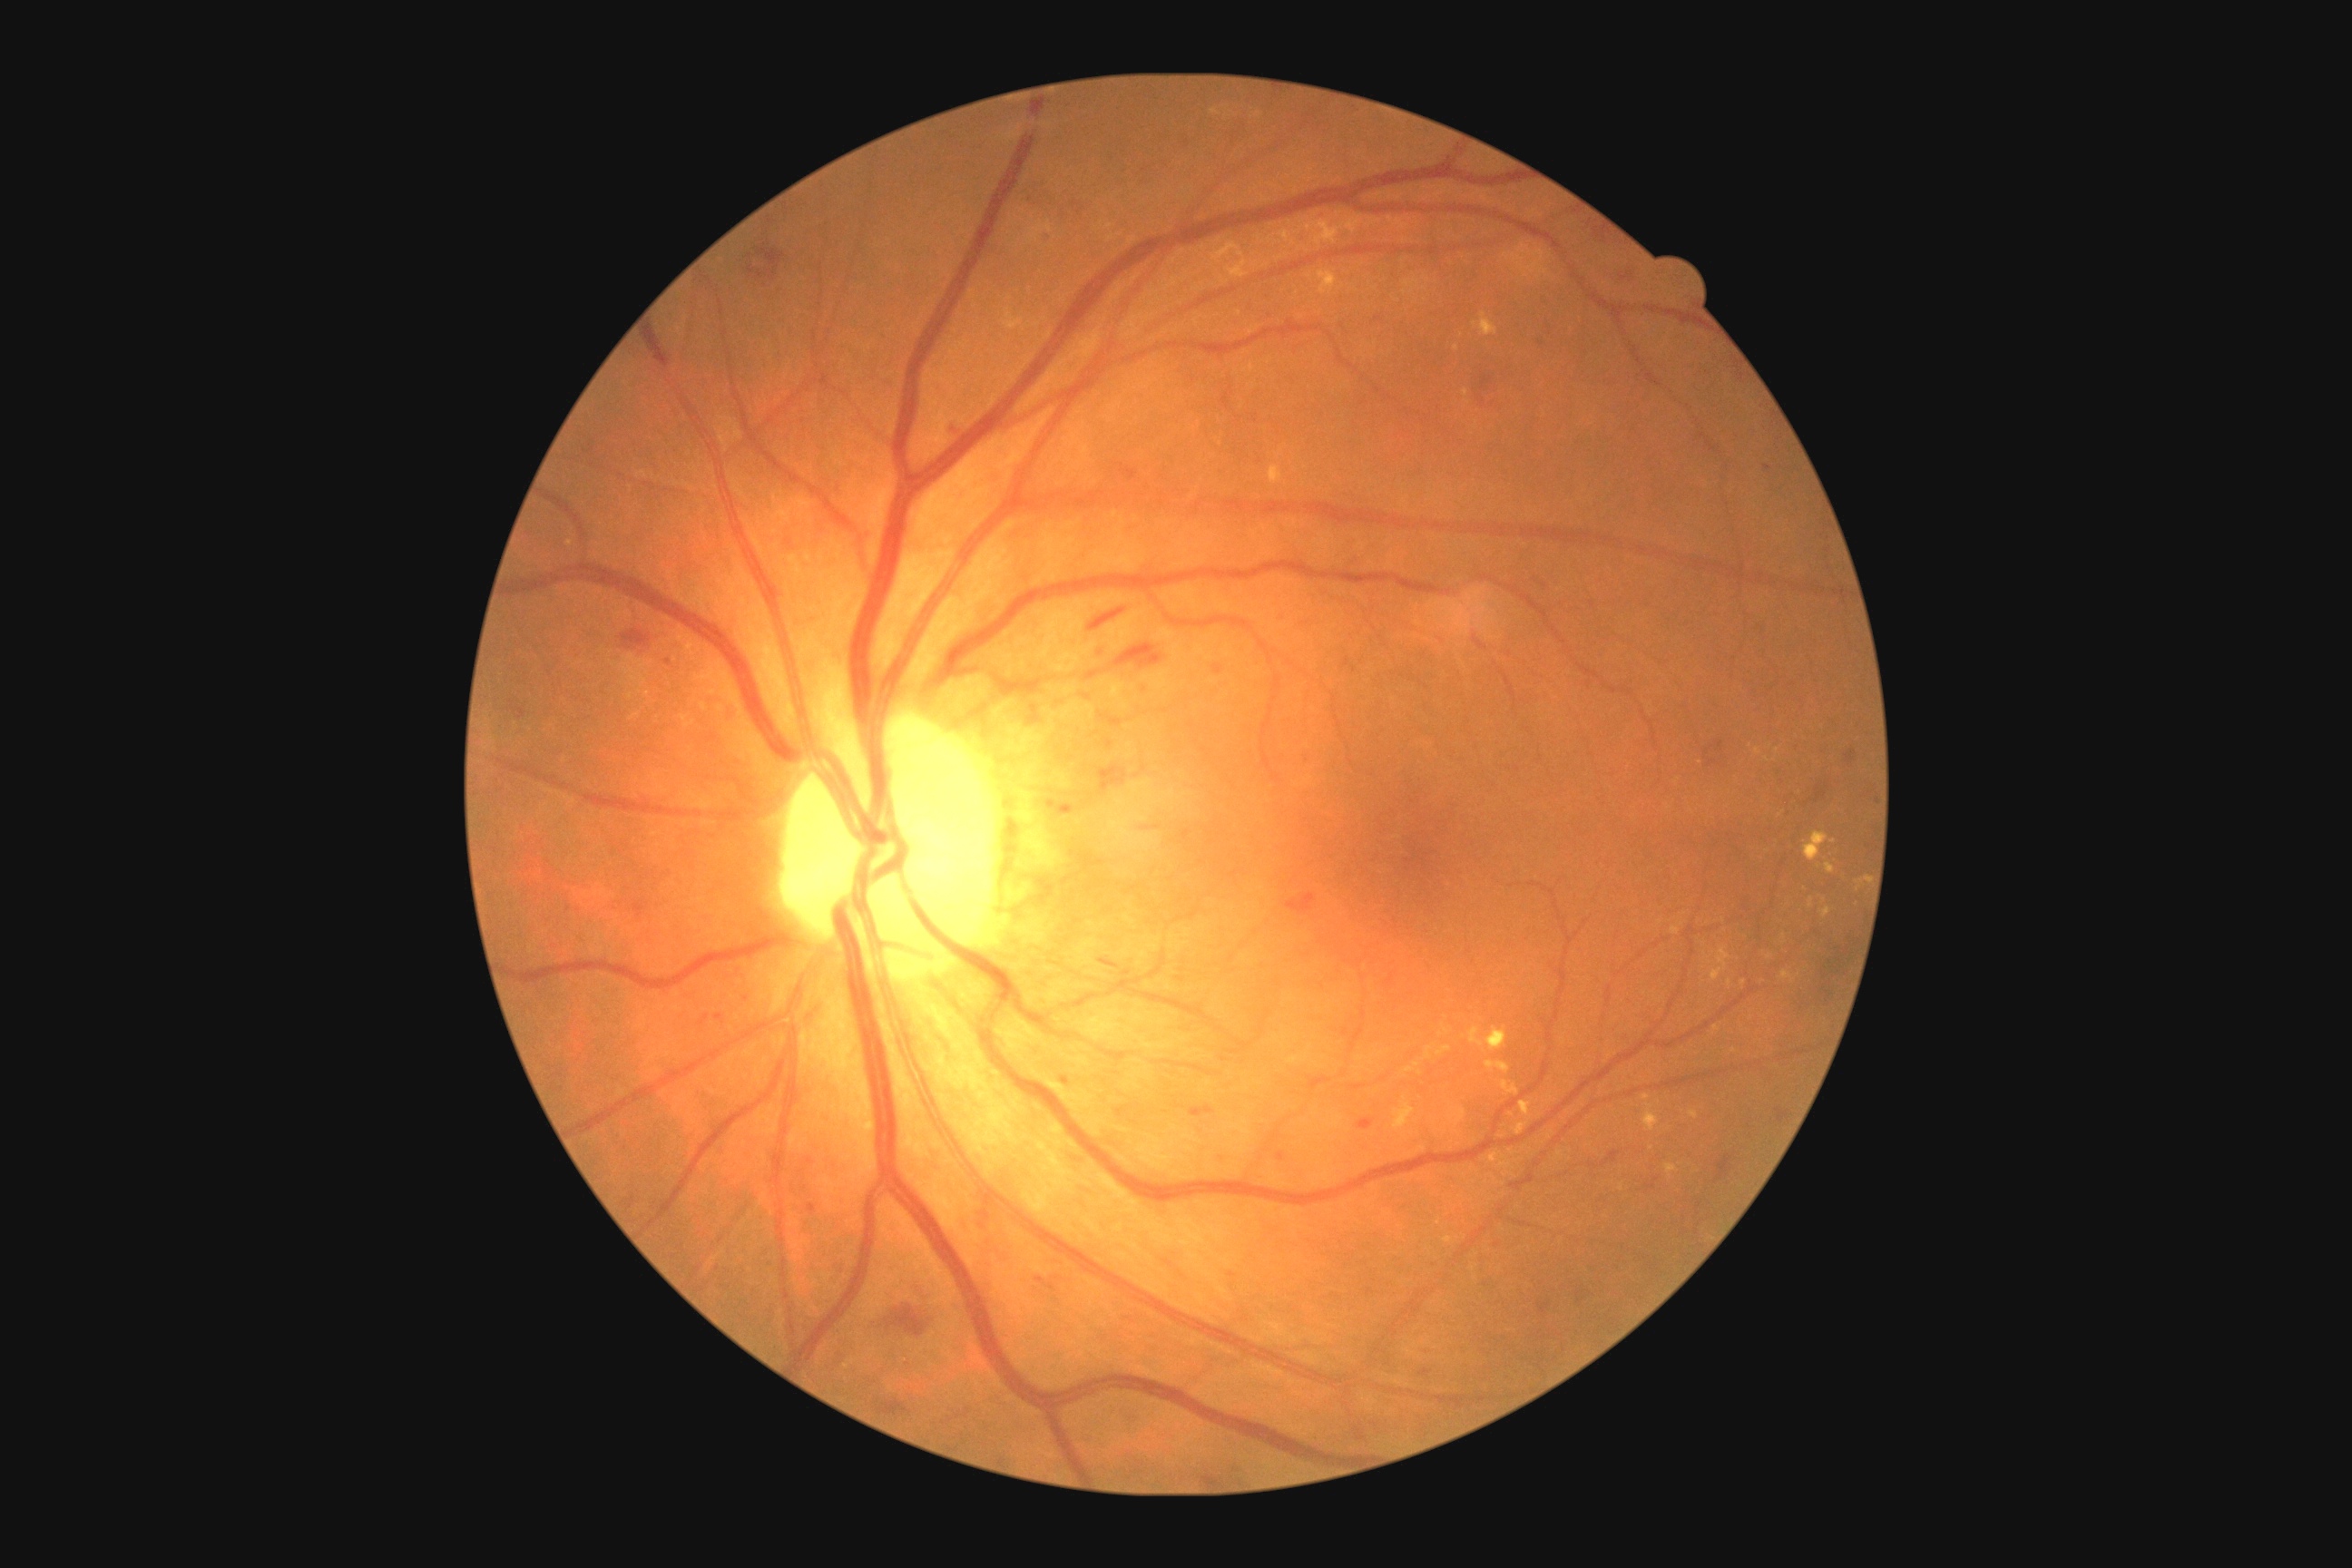

partial: true
dr_grade: 2
dr_grade_name: moderate NPDR
lesions:
  ex:
    - [1436,1046,1451,1057]
    - [1781,970,1796,983]
    - [1464,389,1469,398]
    - [1500,1162,1511,1168]
    - [1480,313,1498,337]
    - [1426,1046,1435,1059]
    - [1857,876,1868,883]
    - [1393,1104,1415,1130]
    - [1469,1028,1507,1052]
    - [1502,1081,1520,1095]
  ex_small_approx:
    - 1717, 1029
    - 1734, 1050
    - 570, 544
    - 1770, 957
    - 1511, 1153
  he:
    - [1418,1351,1435,1357]
    - [634,903,645,917]
    - [1122,469,1137,482]
    - [1097,765,1126,790]
    - [1135,681,1152,696]
    - [1538,1304,1551,1315]
    - [1024,700,1044,727]
    - [1063,1077,1070,1086]
    - [1190,1106,1215,1119]
    - [887,1306,925,1337]
    - [1213,665,1224,676]
  he_small_approx:
    - 750, 257
    - 1040, 1281
    - 752, 271
    - 669, 662